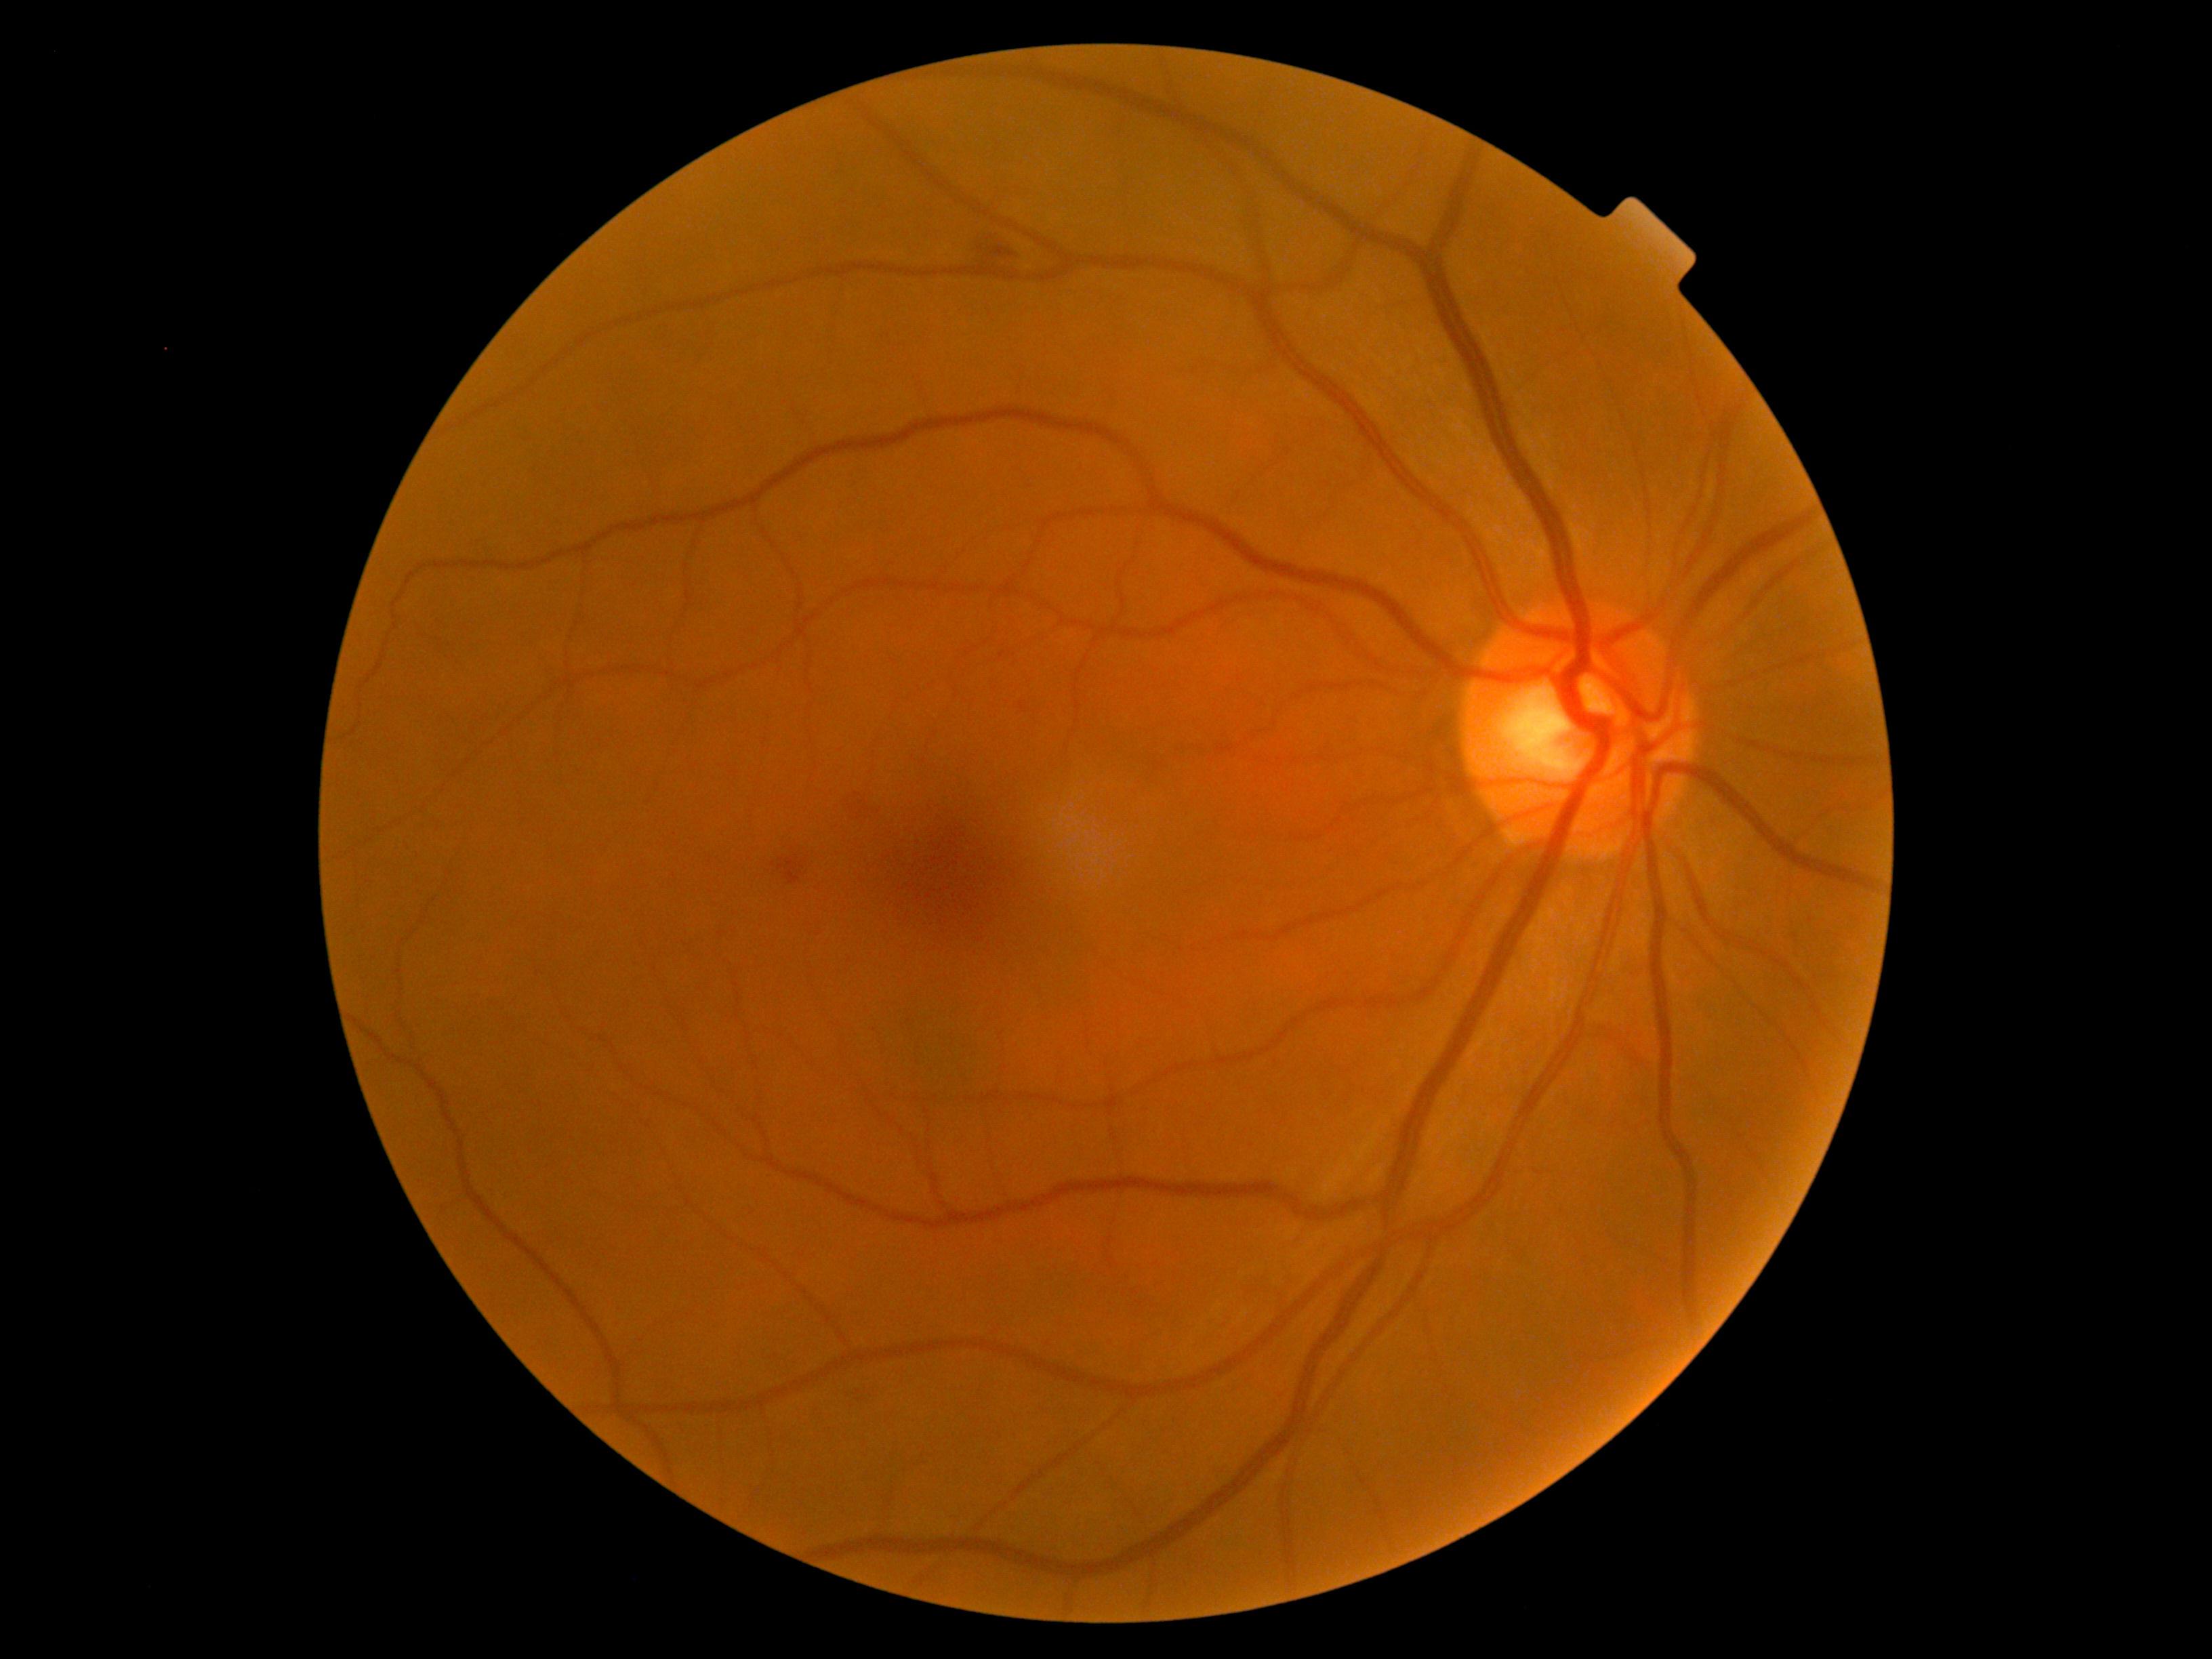

Retinopathy grade: 2. Disease class: non-proliferative diabetic retinopathy.